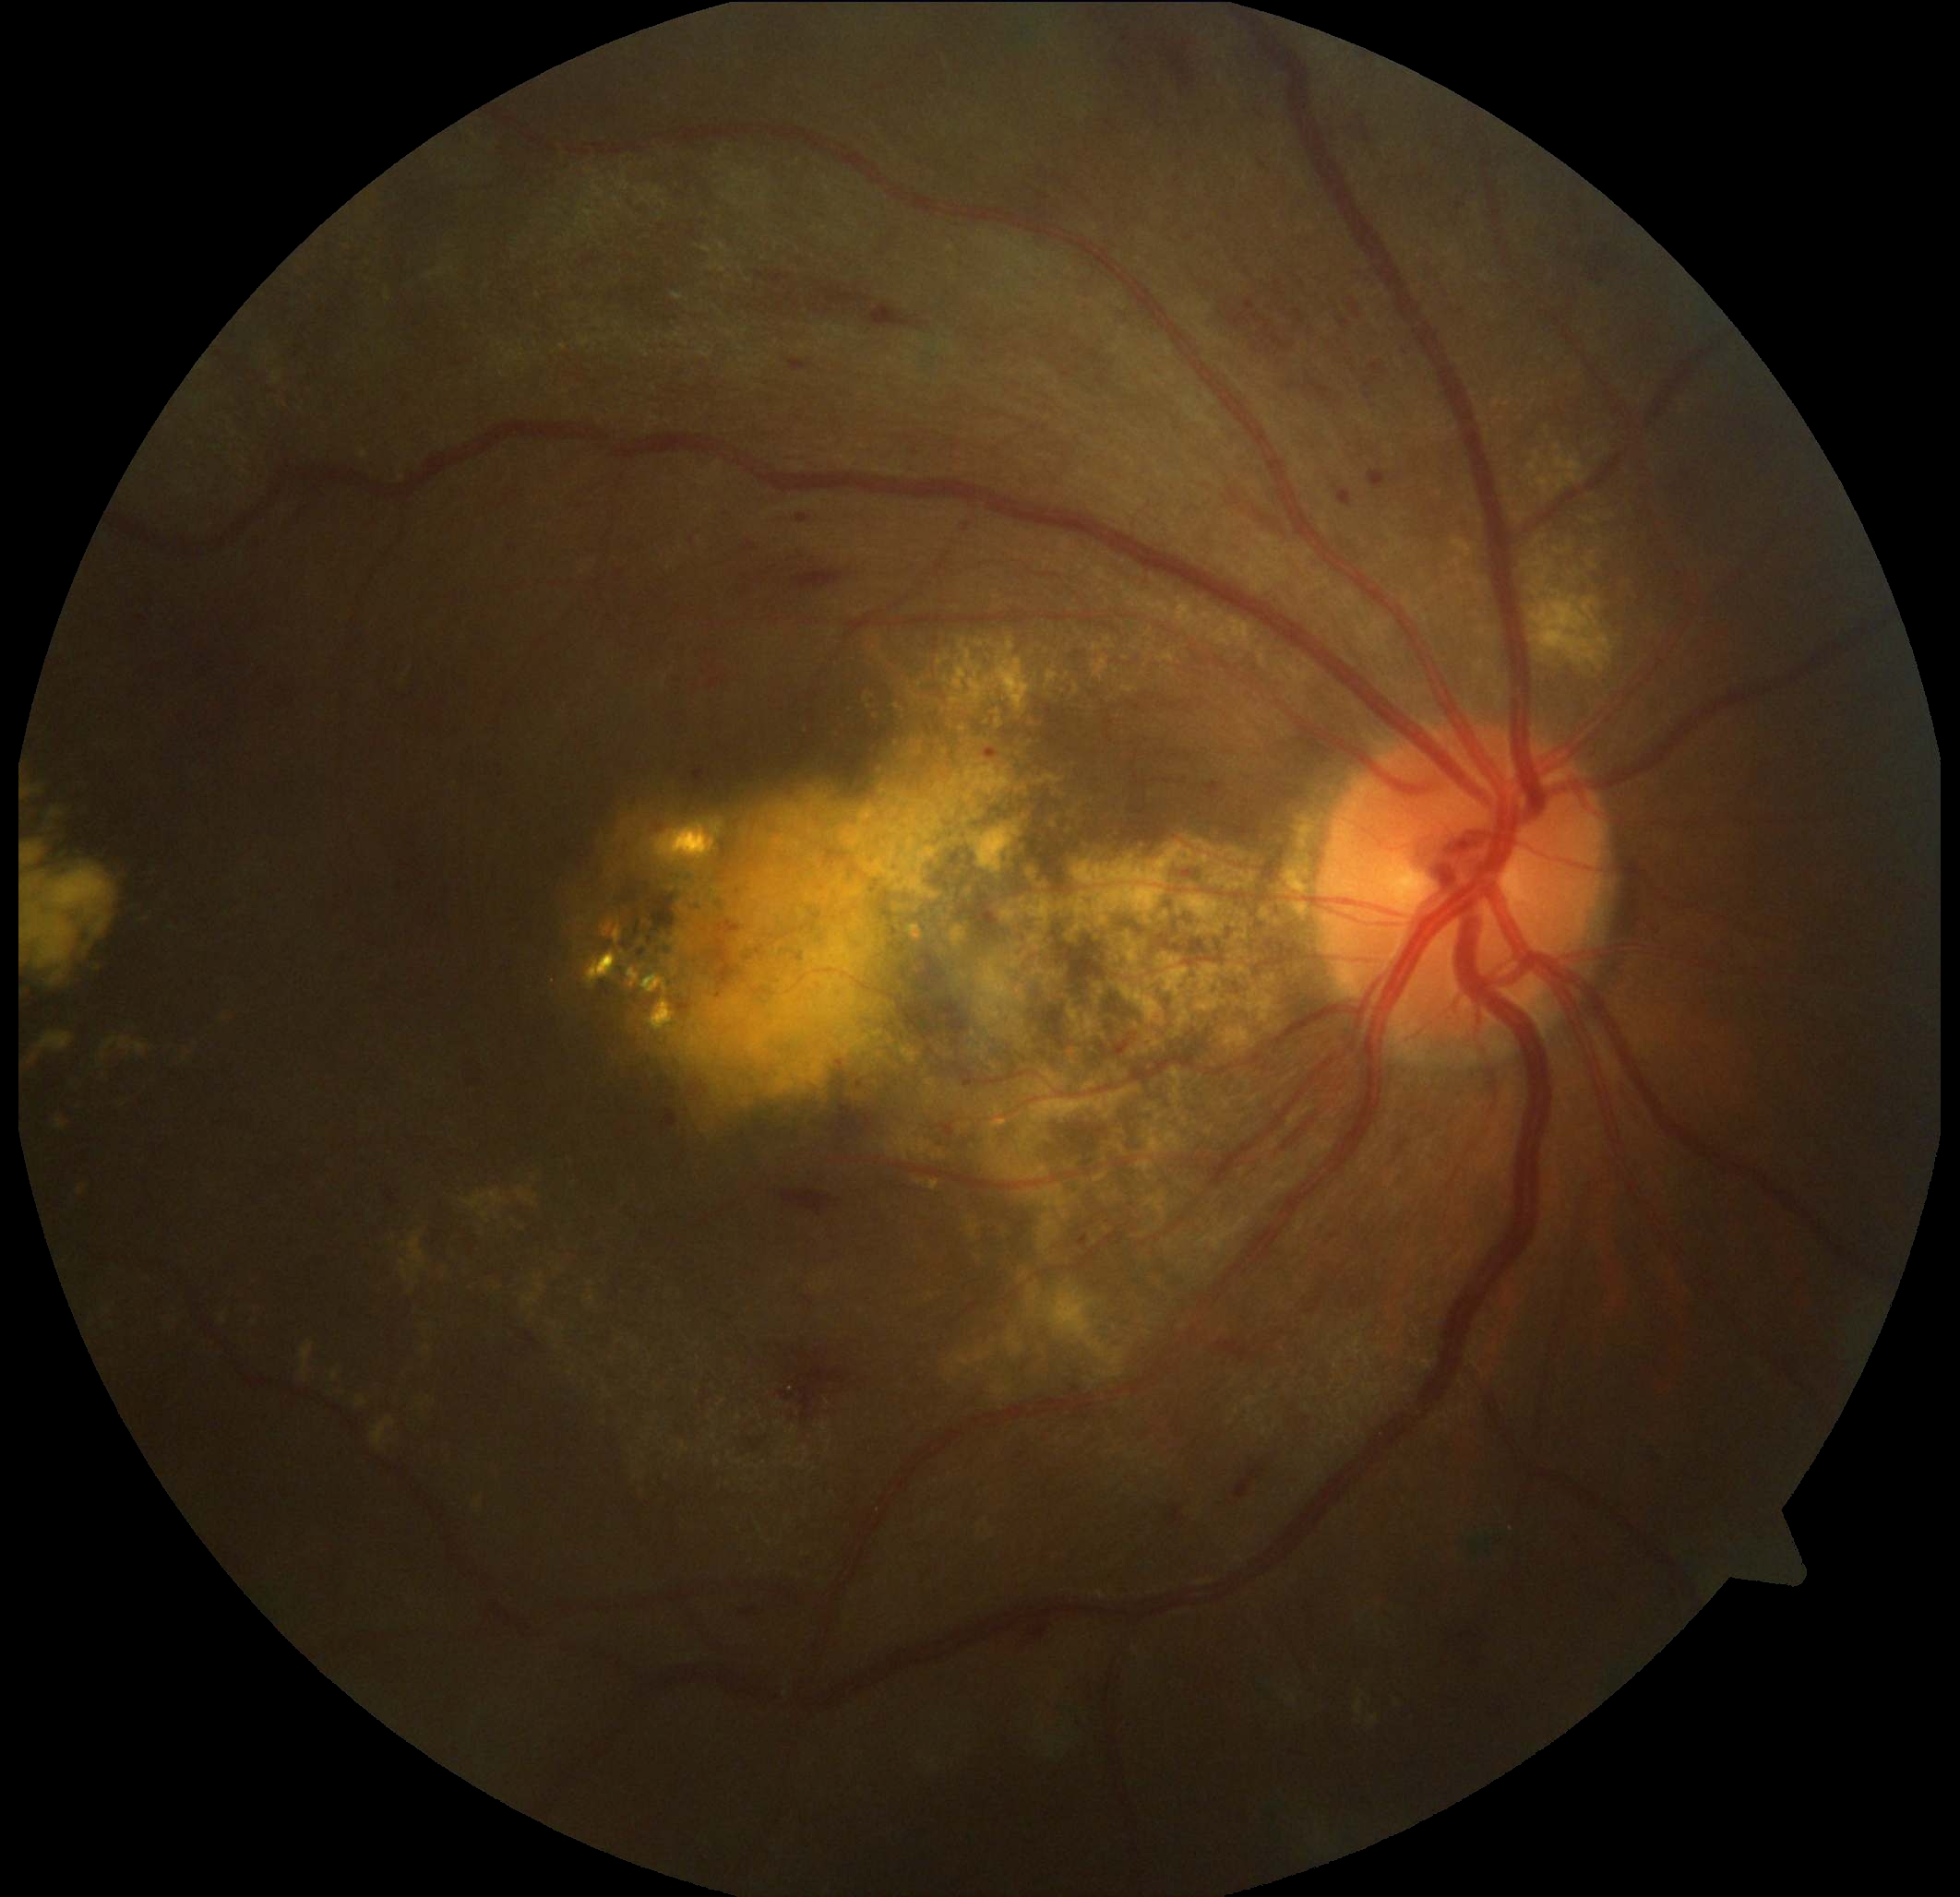

Diabetic retinopathy (DR) is grade 2.